Diabetic retinopathy graded by the modified Davis classification:
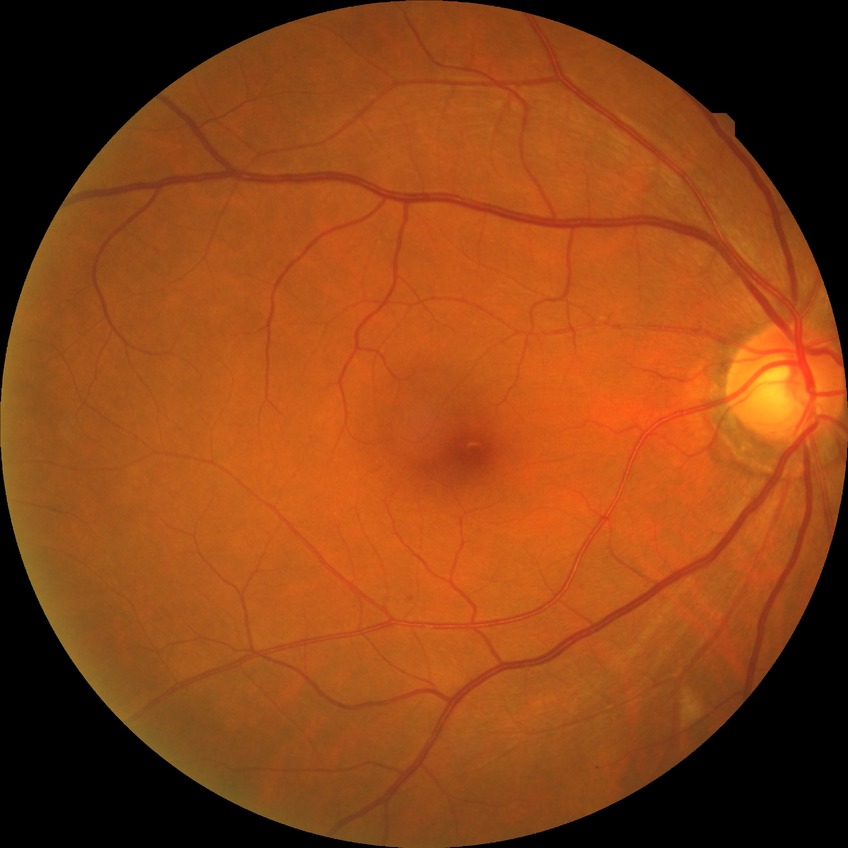

DR: NDR. No DR findings.